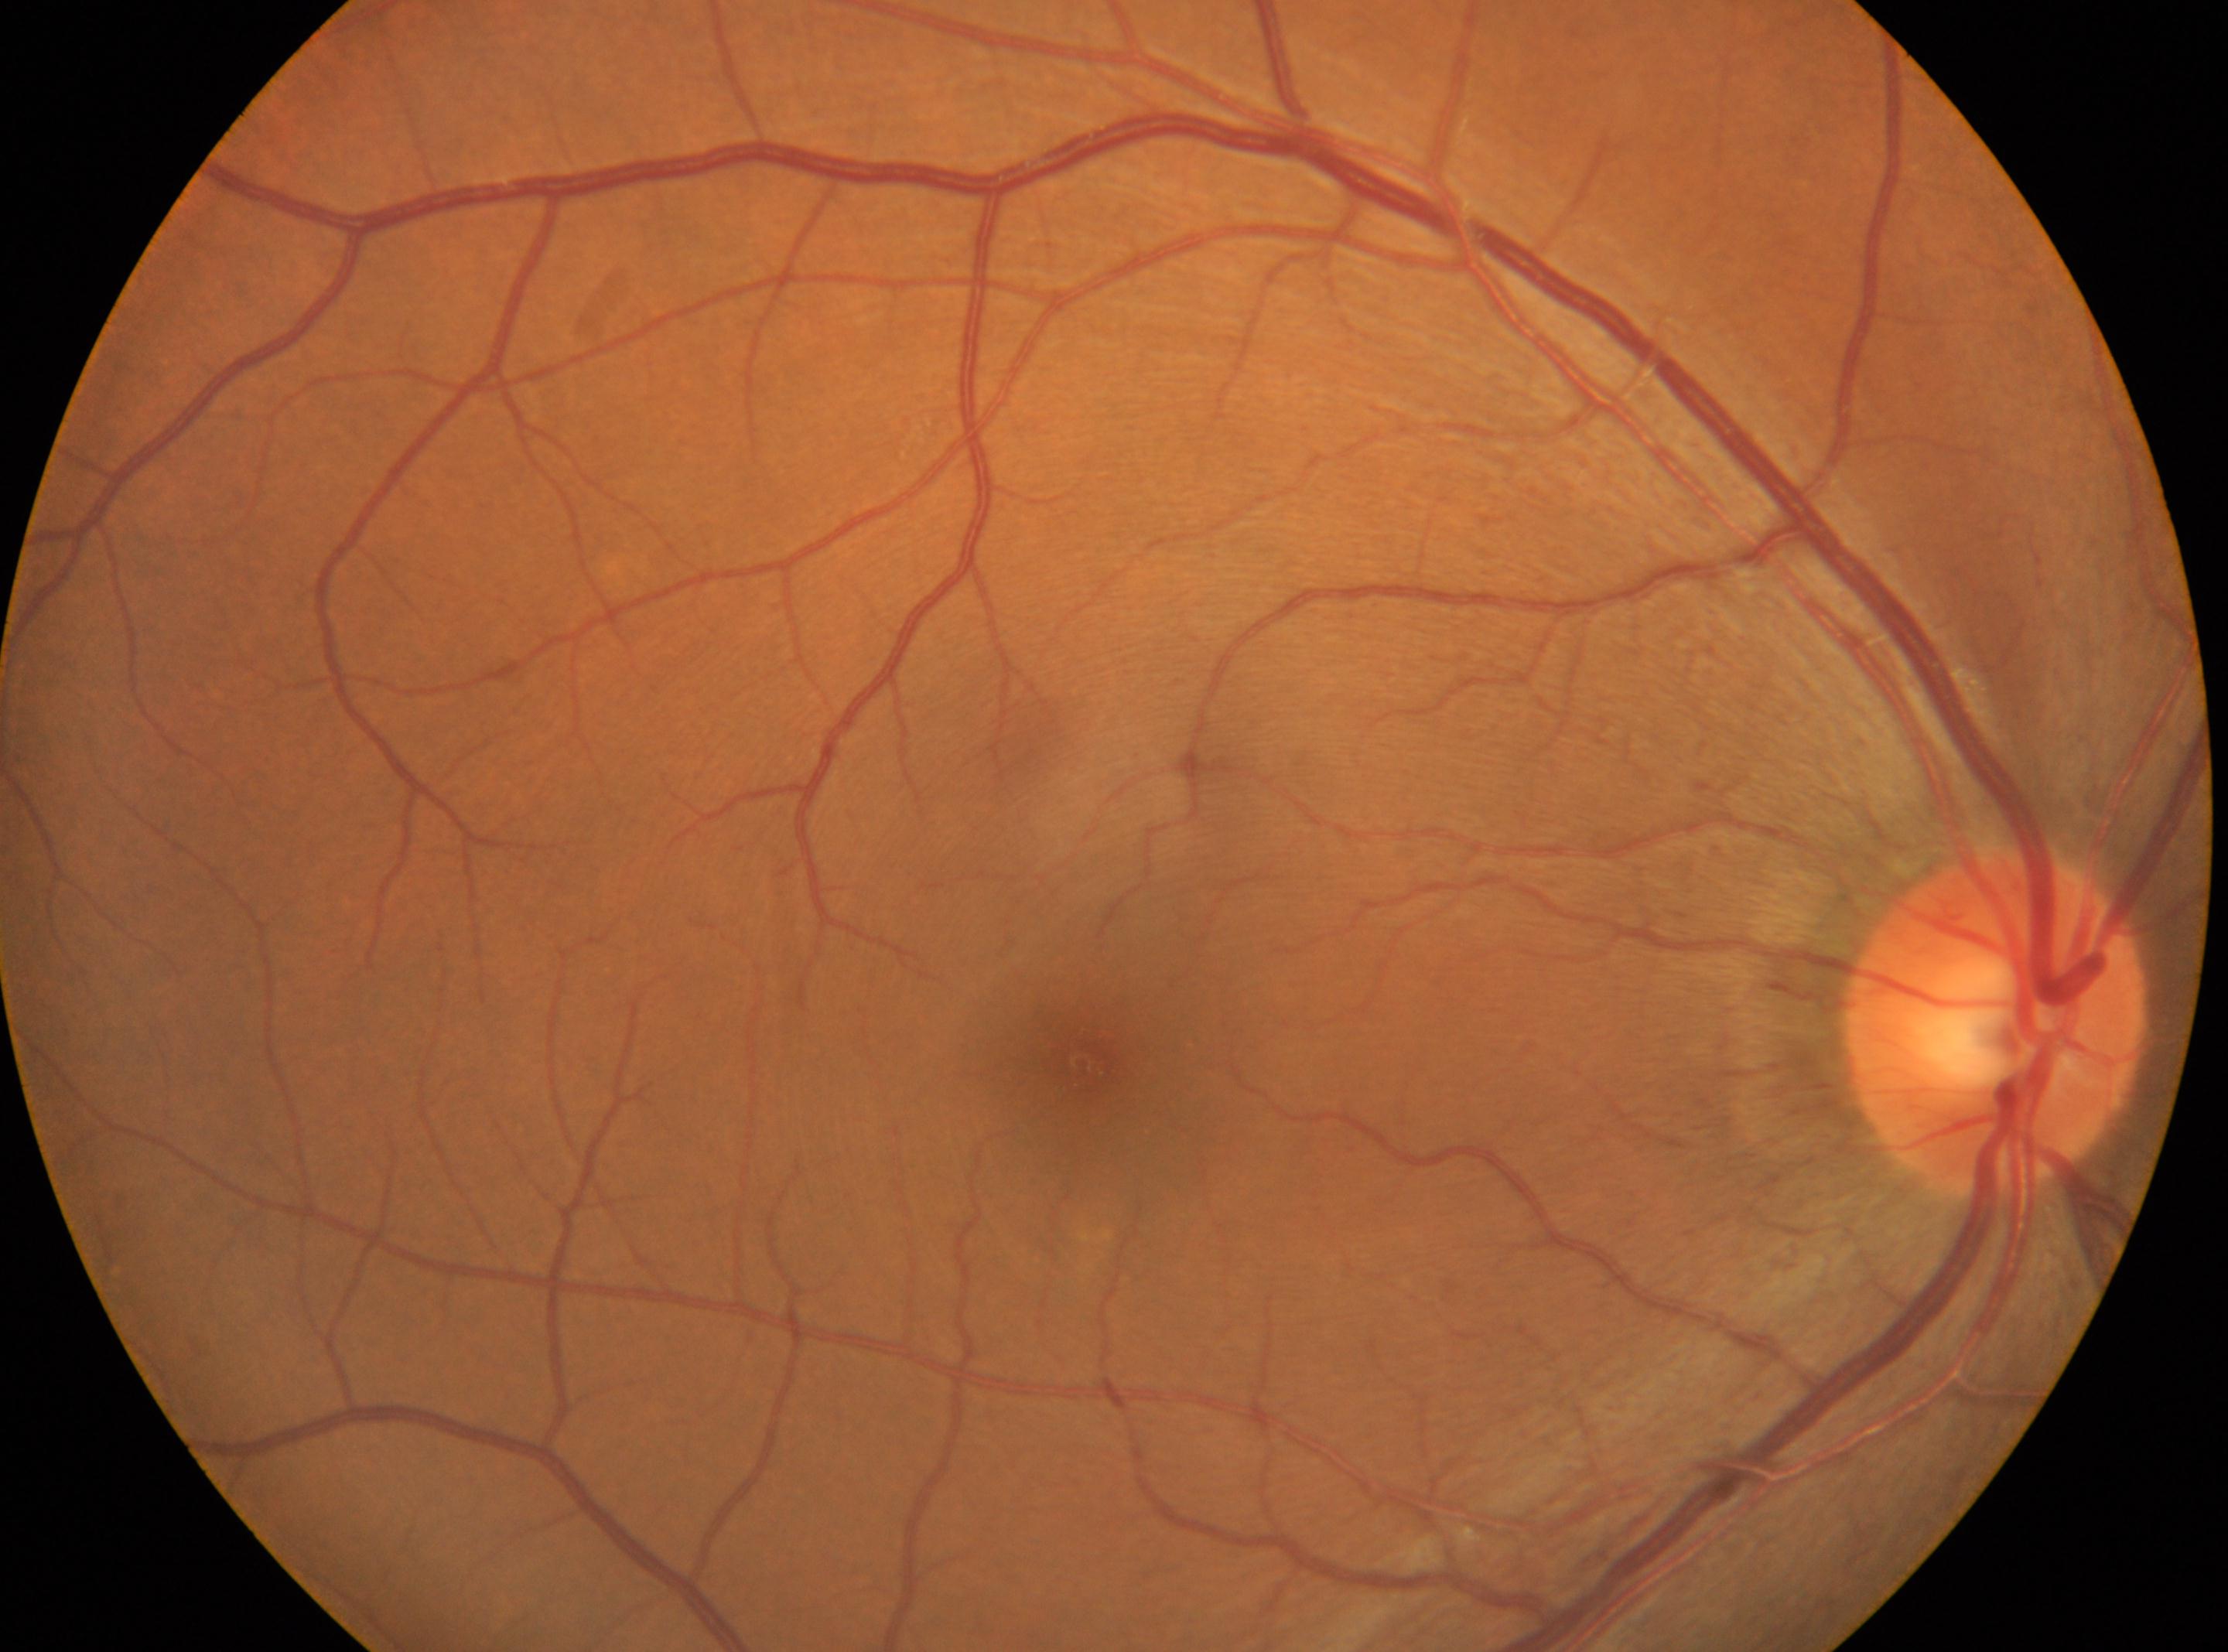

eye: oculus dexter
optic_disc: 1996, 1023
dr_grade: 0
fovea: 1080, 1063